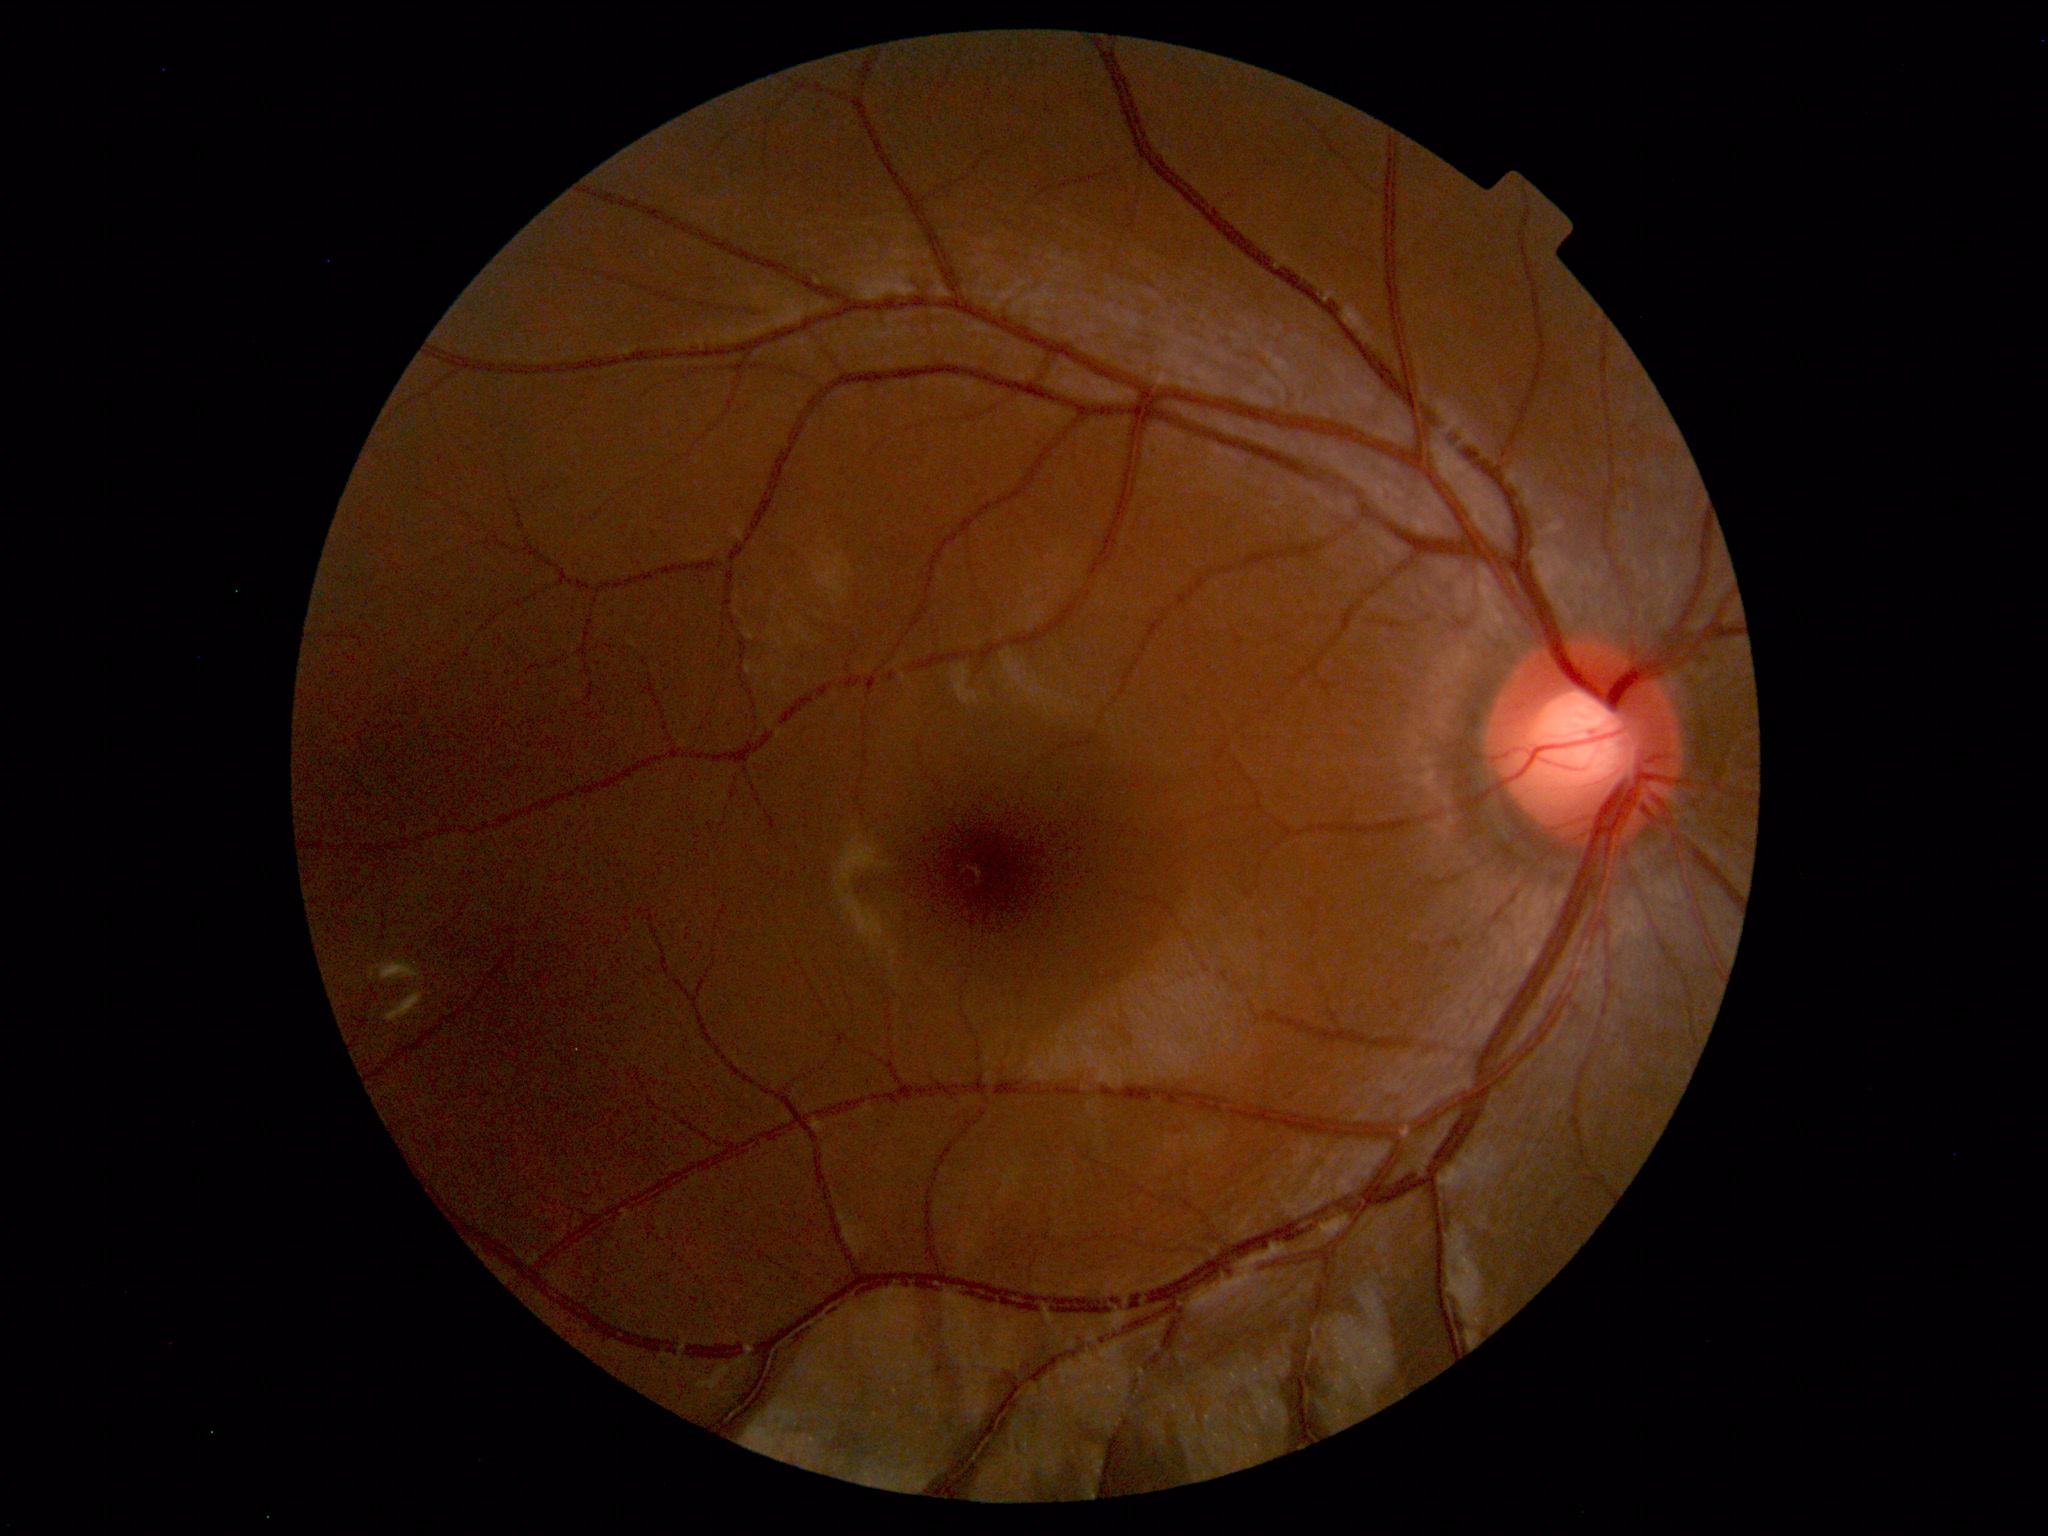
Normal fundus. No pathology identified.